FOV: 45 degrees:
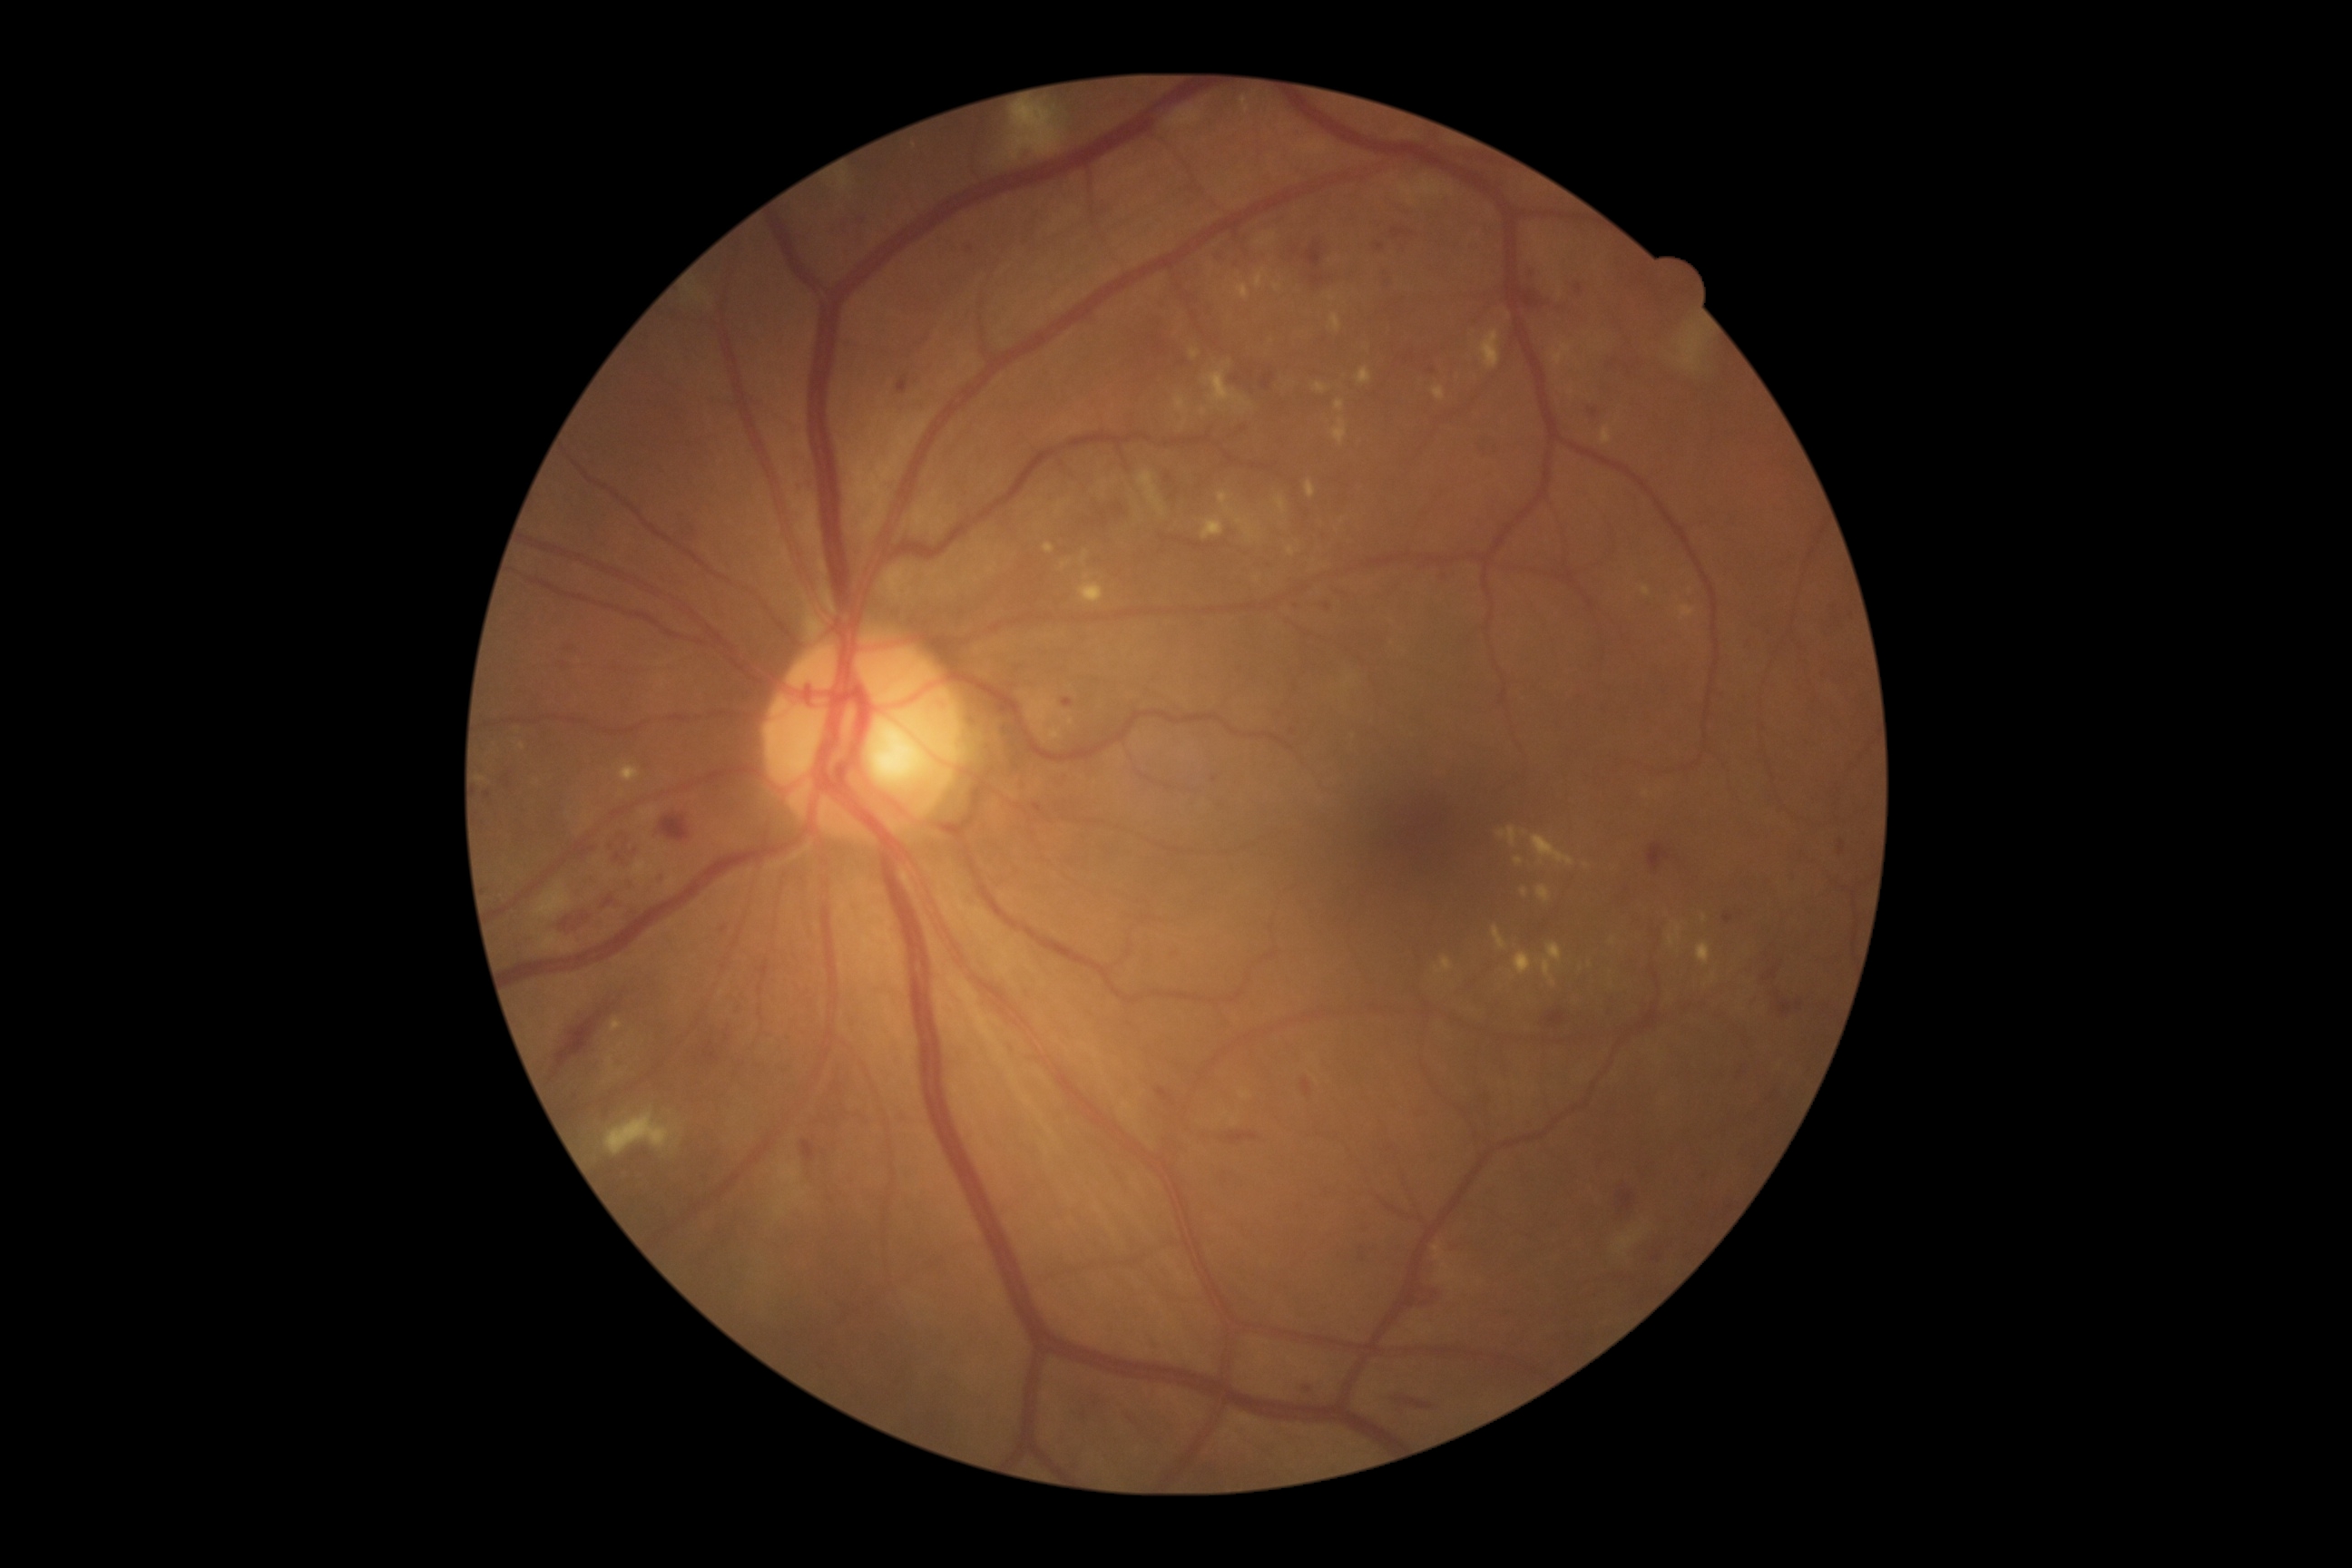 Retinopathy grade: 2 (moderate NPDR).